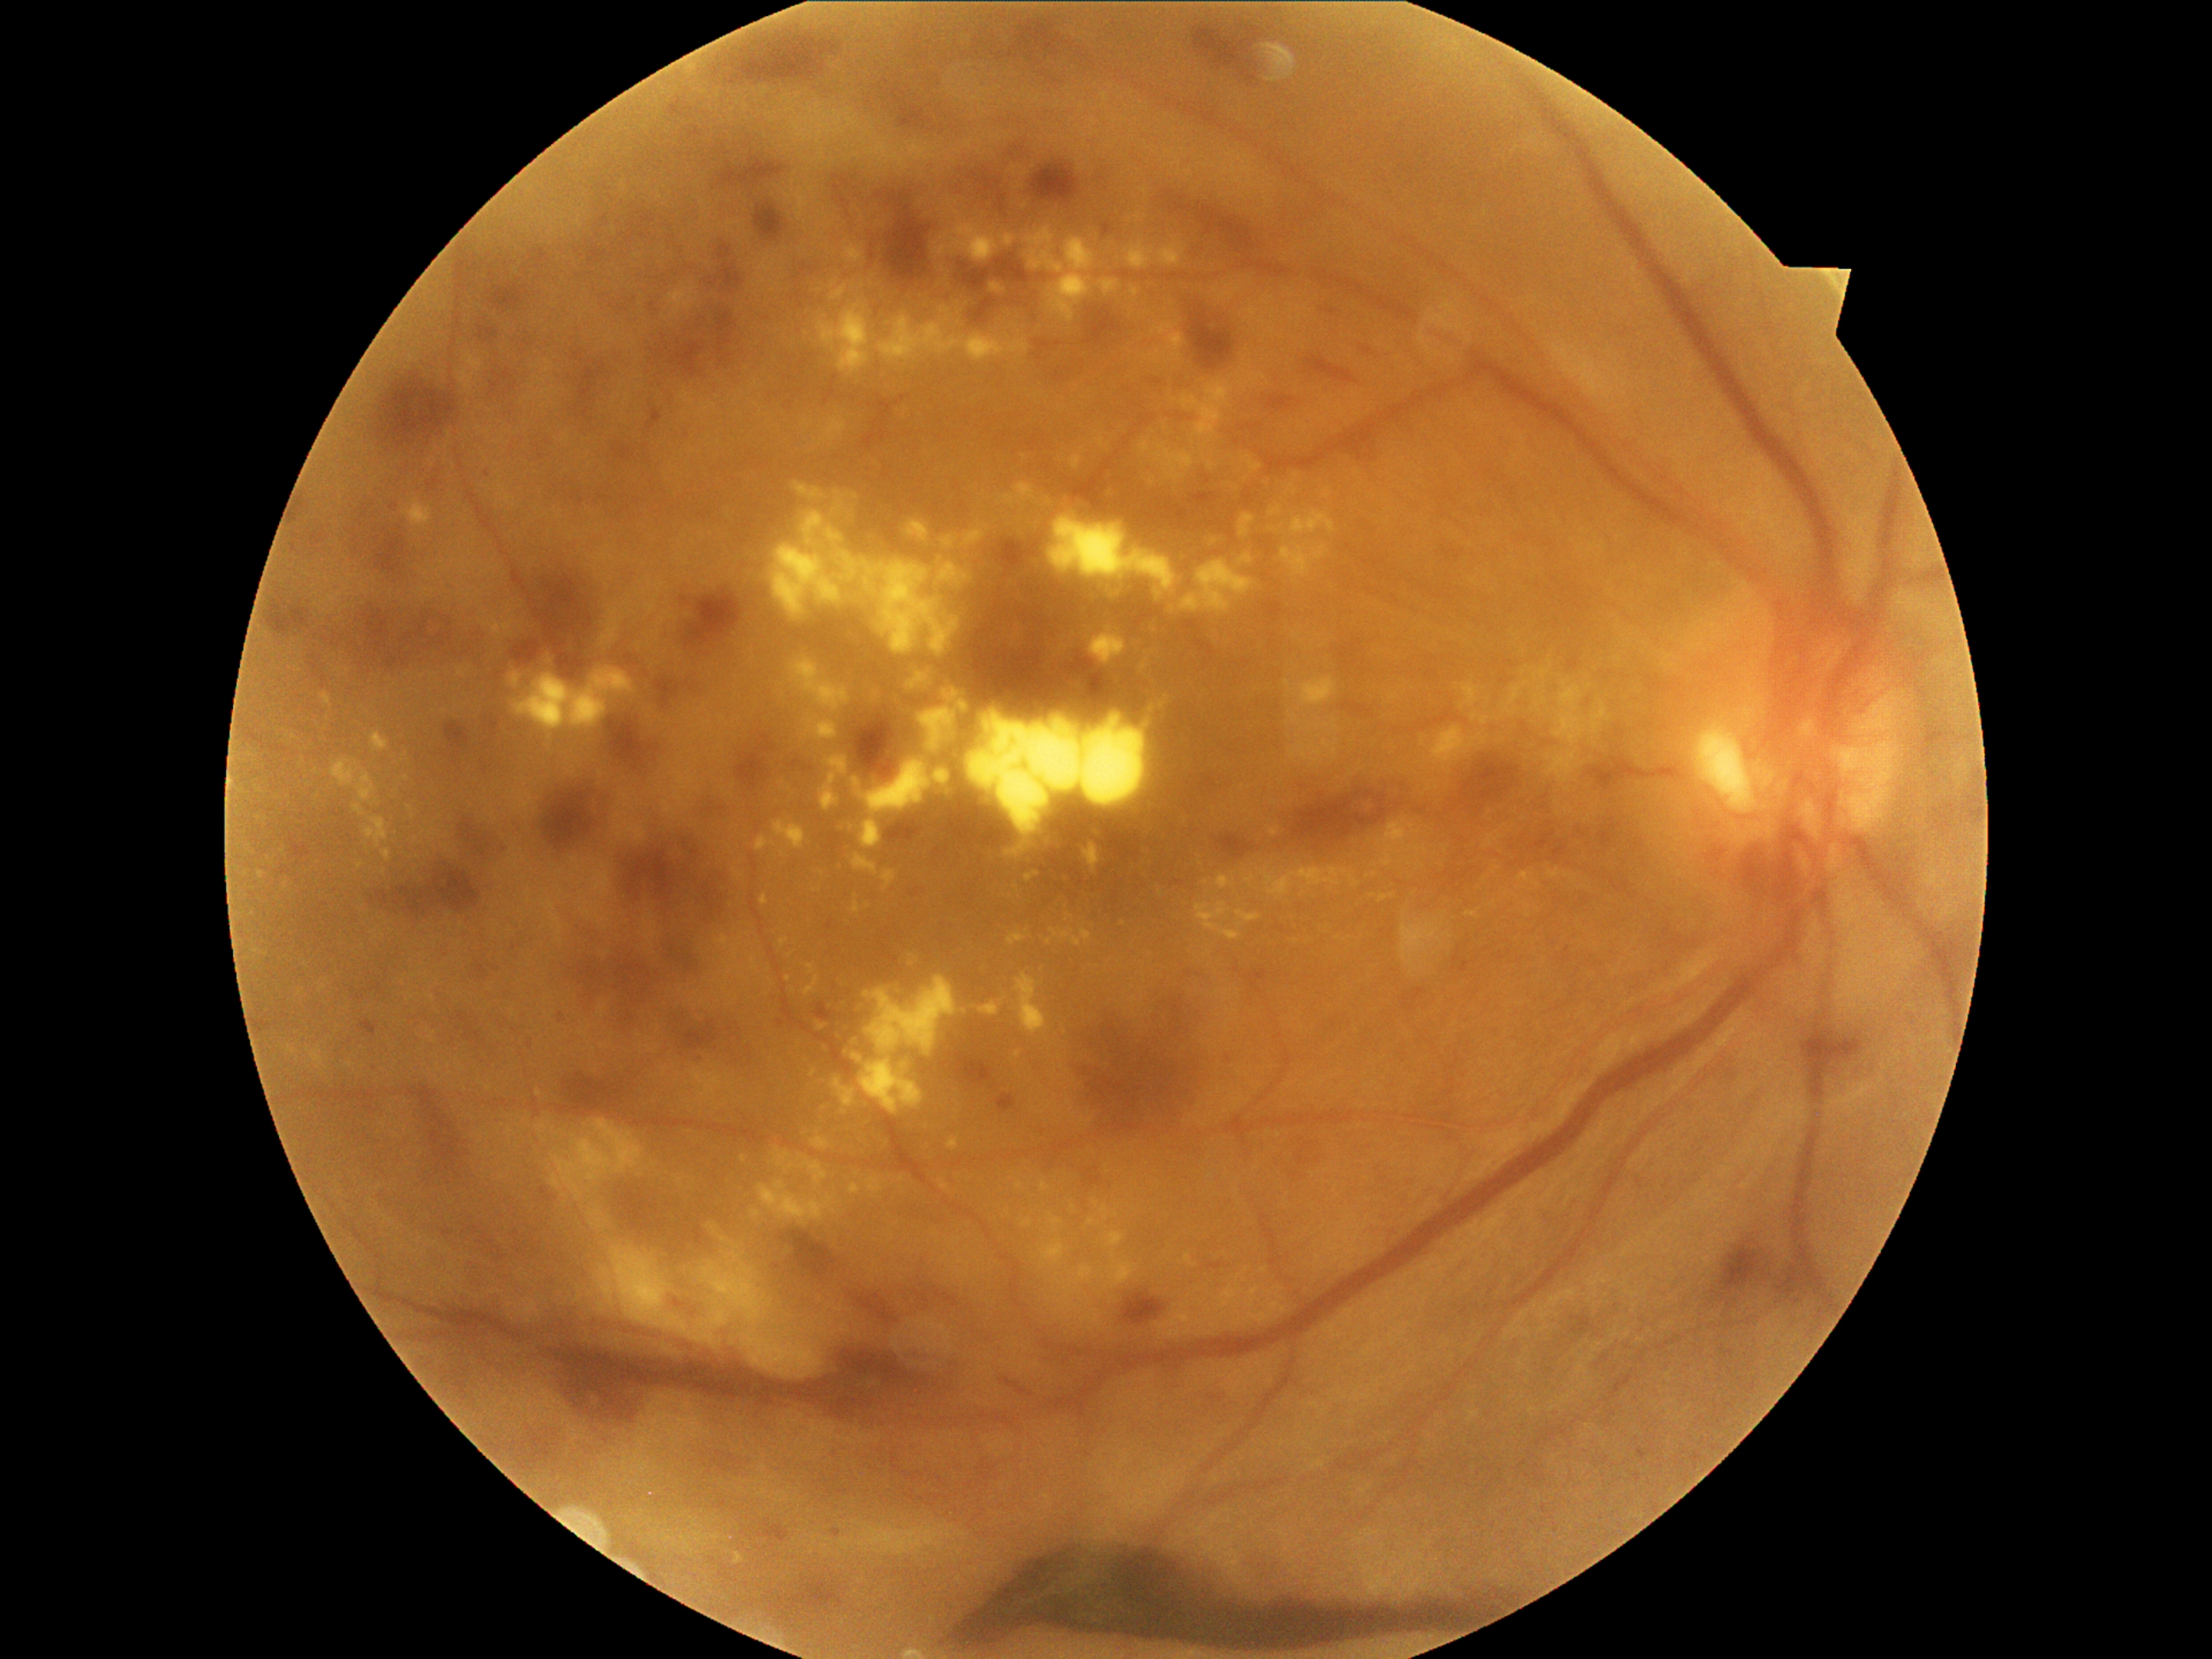 <lesions partial="true">
  <dr_grade>4</dr_grade>
  <ex partial="true">820:759:849:812 | 1421:735:1428:748 | 1158:245:1182:269 | 789:658:851:713 | 735:1552:745:1564 | 1180:245:1184:253 | 830:282:847:303 | 1132:288:1139:298 | 1151:477:1156:487 | 1158:1312:1190:1339 | 1008:931:1027:946 | 962:702:1158:856 | 1289:713:1301:726 | 1165:470:1182:484</ex>
  <ex_small_approx><point>852, 828</point> | <point>1246, 1271</point> | <point>1296, 494</point> | <point>749, 946</point> | <point>1287, 723</point> | <point>789, 979</point></ex_small_approx>
  <ma partial="true">1190:494:1218:508 | 999:1377:1035:1397 | 999:144:1027:165 | 1339:641:1363:667 | 711:279:719:286 | 359:1020:378:1035 | 1194:637:1216:658 | 822:42:839:55 | 1102:223:1114:236 | 293:544:296:552 | 689:129:701:139 | 834:177:853:194 | 1498:953:1506:962 | 1361:347:1373:356 | 955:1052:996:1088</ma>
  <ma_small_approx><point>1641, 1182</point> | <point>958, 188</point></ma_small_approx>
  <he partial="true">579:361:607:407 | 1836:1039:1863:1062 | 793:1231:837:1283 | 559:825:731:1025 | 378:373:458:451 | 887:820:924:844 | 1458:747:1525:812 | 742:40:824:81 | 322:600:489:672 | 1194:26:1259:84 | 818:1339:960:1404 | 562:1073:619:1117 | 1197:204:1255:252 | 721:158:784:189 | 393:863:482:916 | 445:723:472:754 | 1308:358:1359:385</he>
  <he_small_approx><point>1838, 1071</point></he_small_approx>
</lesions>